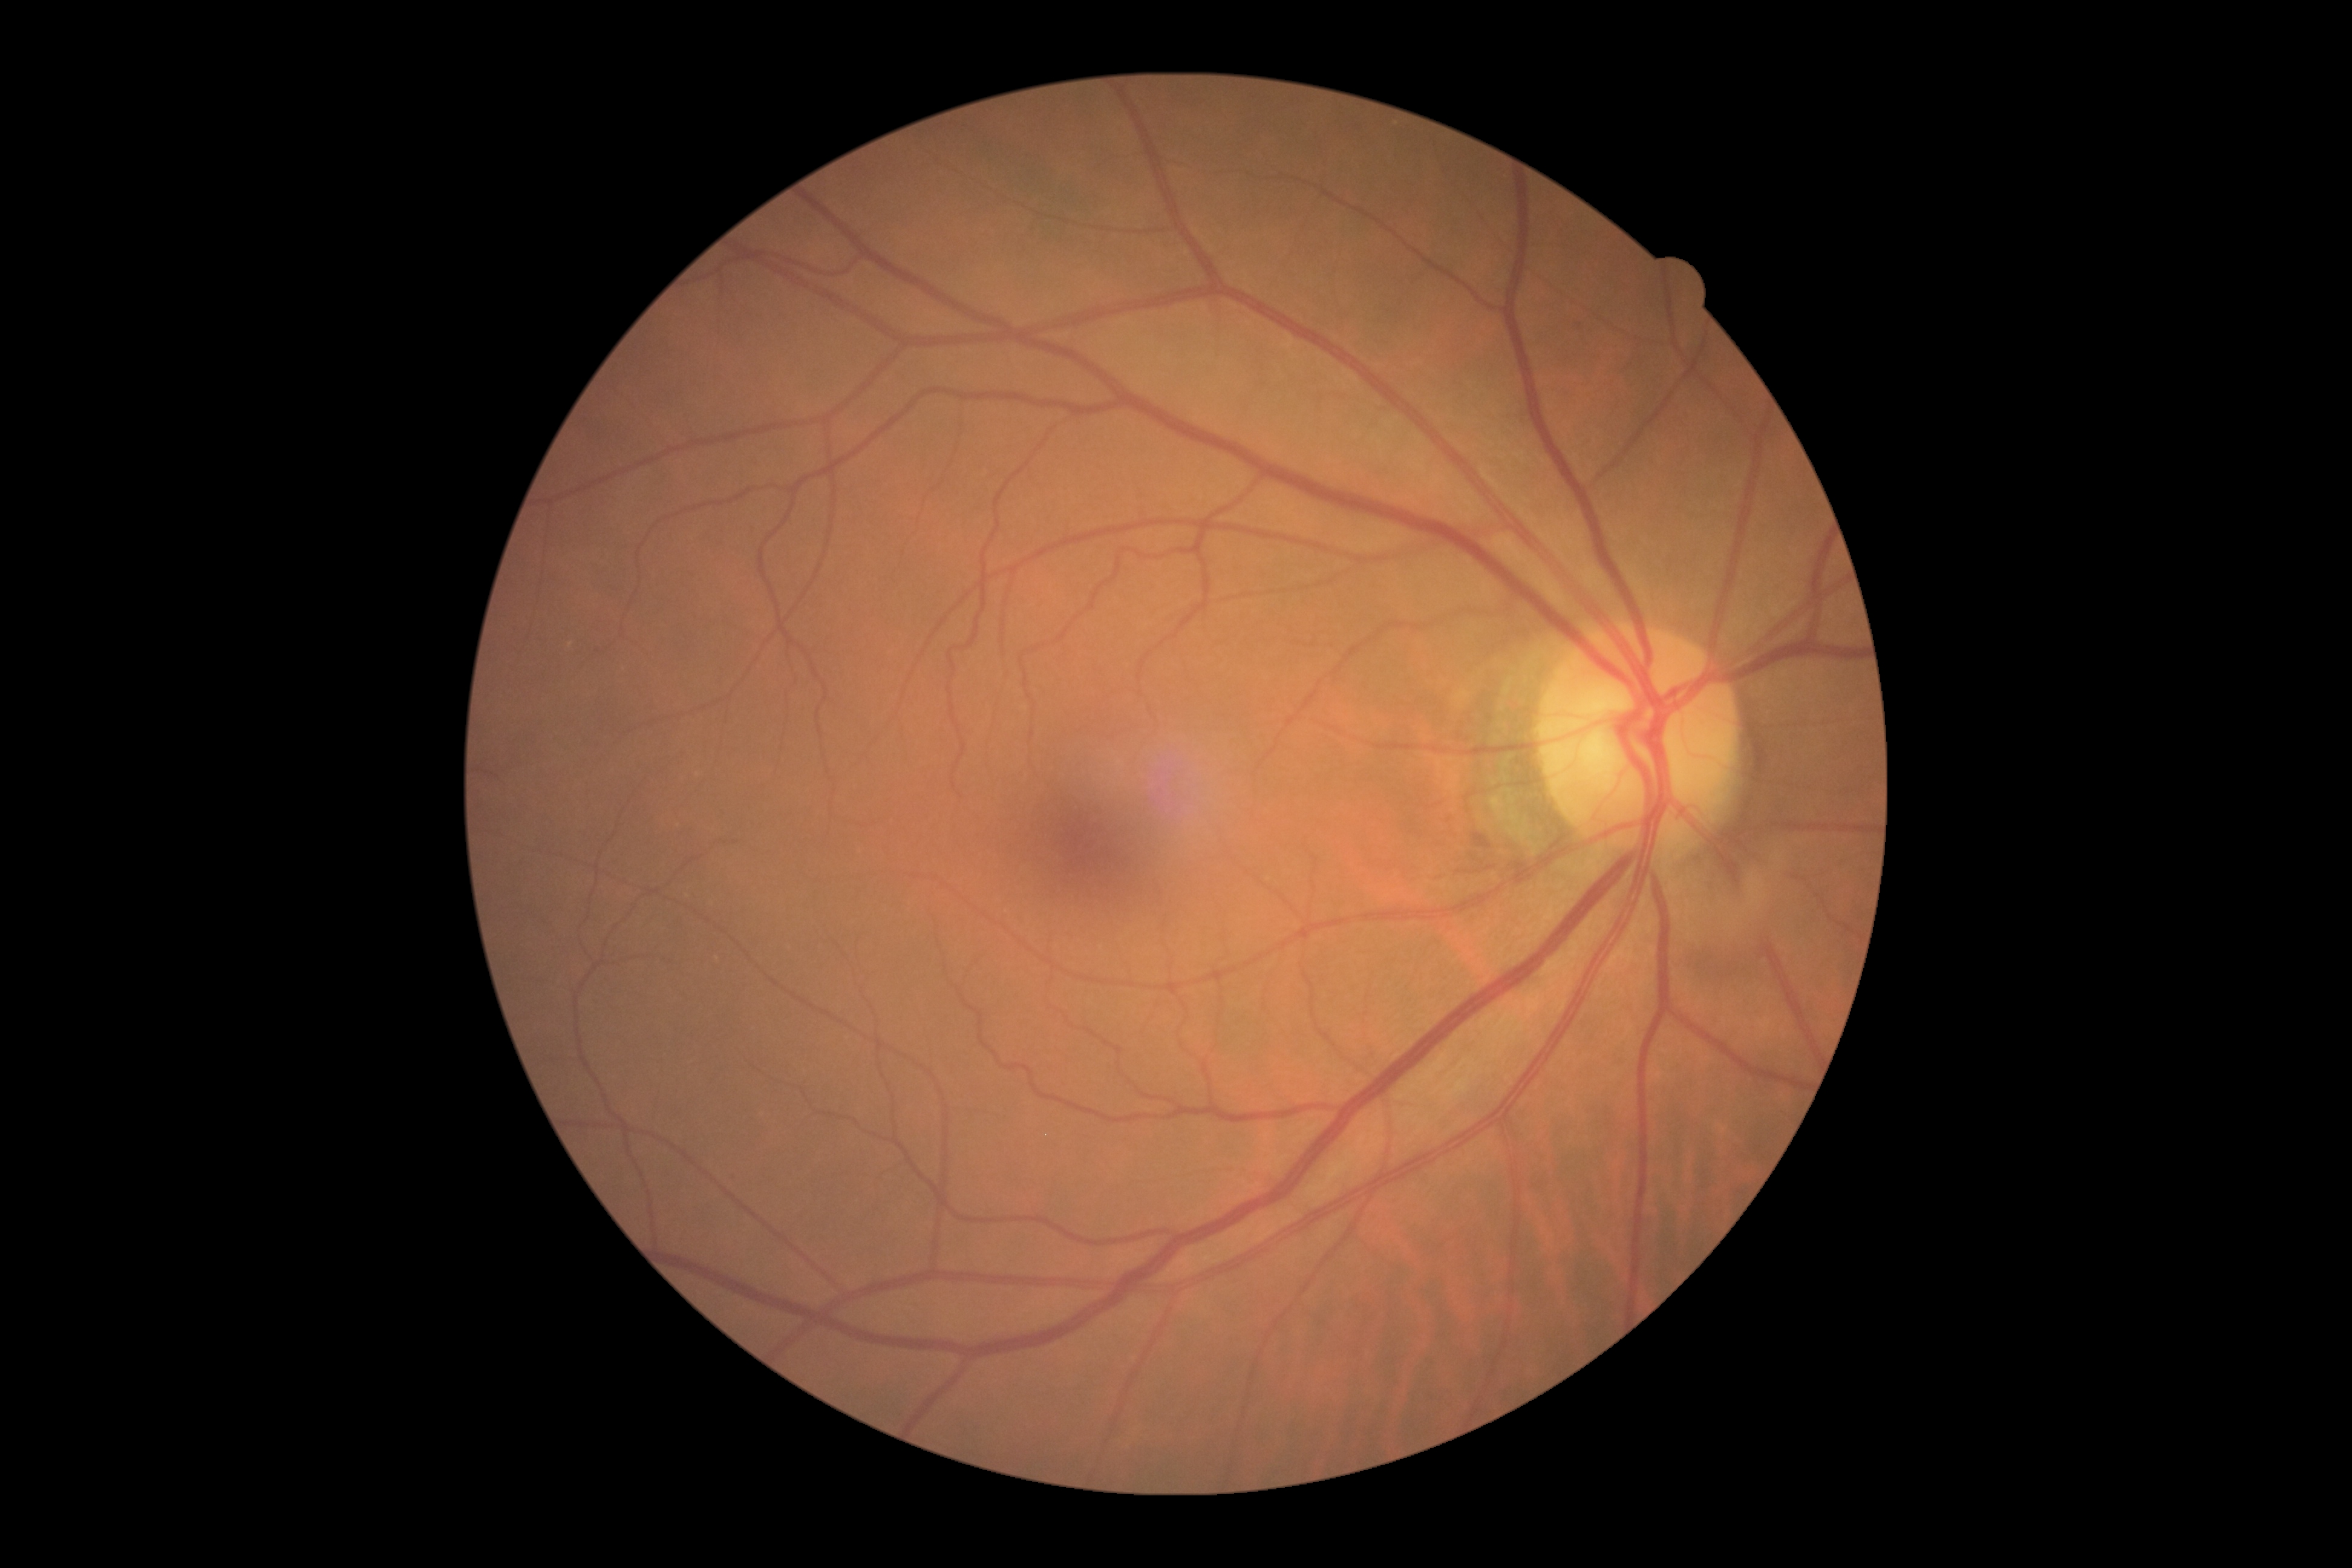
Diabetic retinopathy (DR): grade 0. No apparent diabetic retinopathy.